2352 x 1568 pixels:
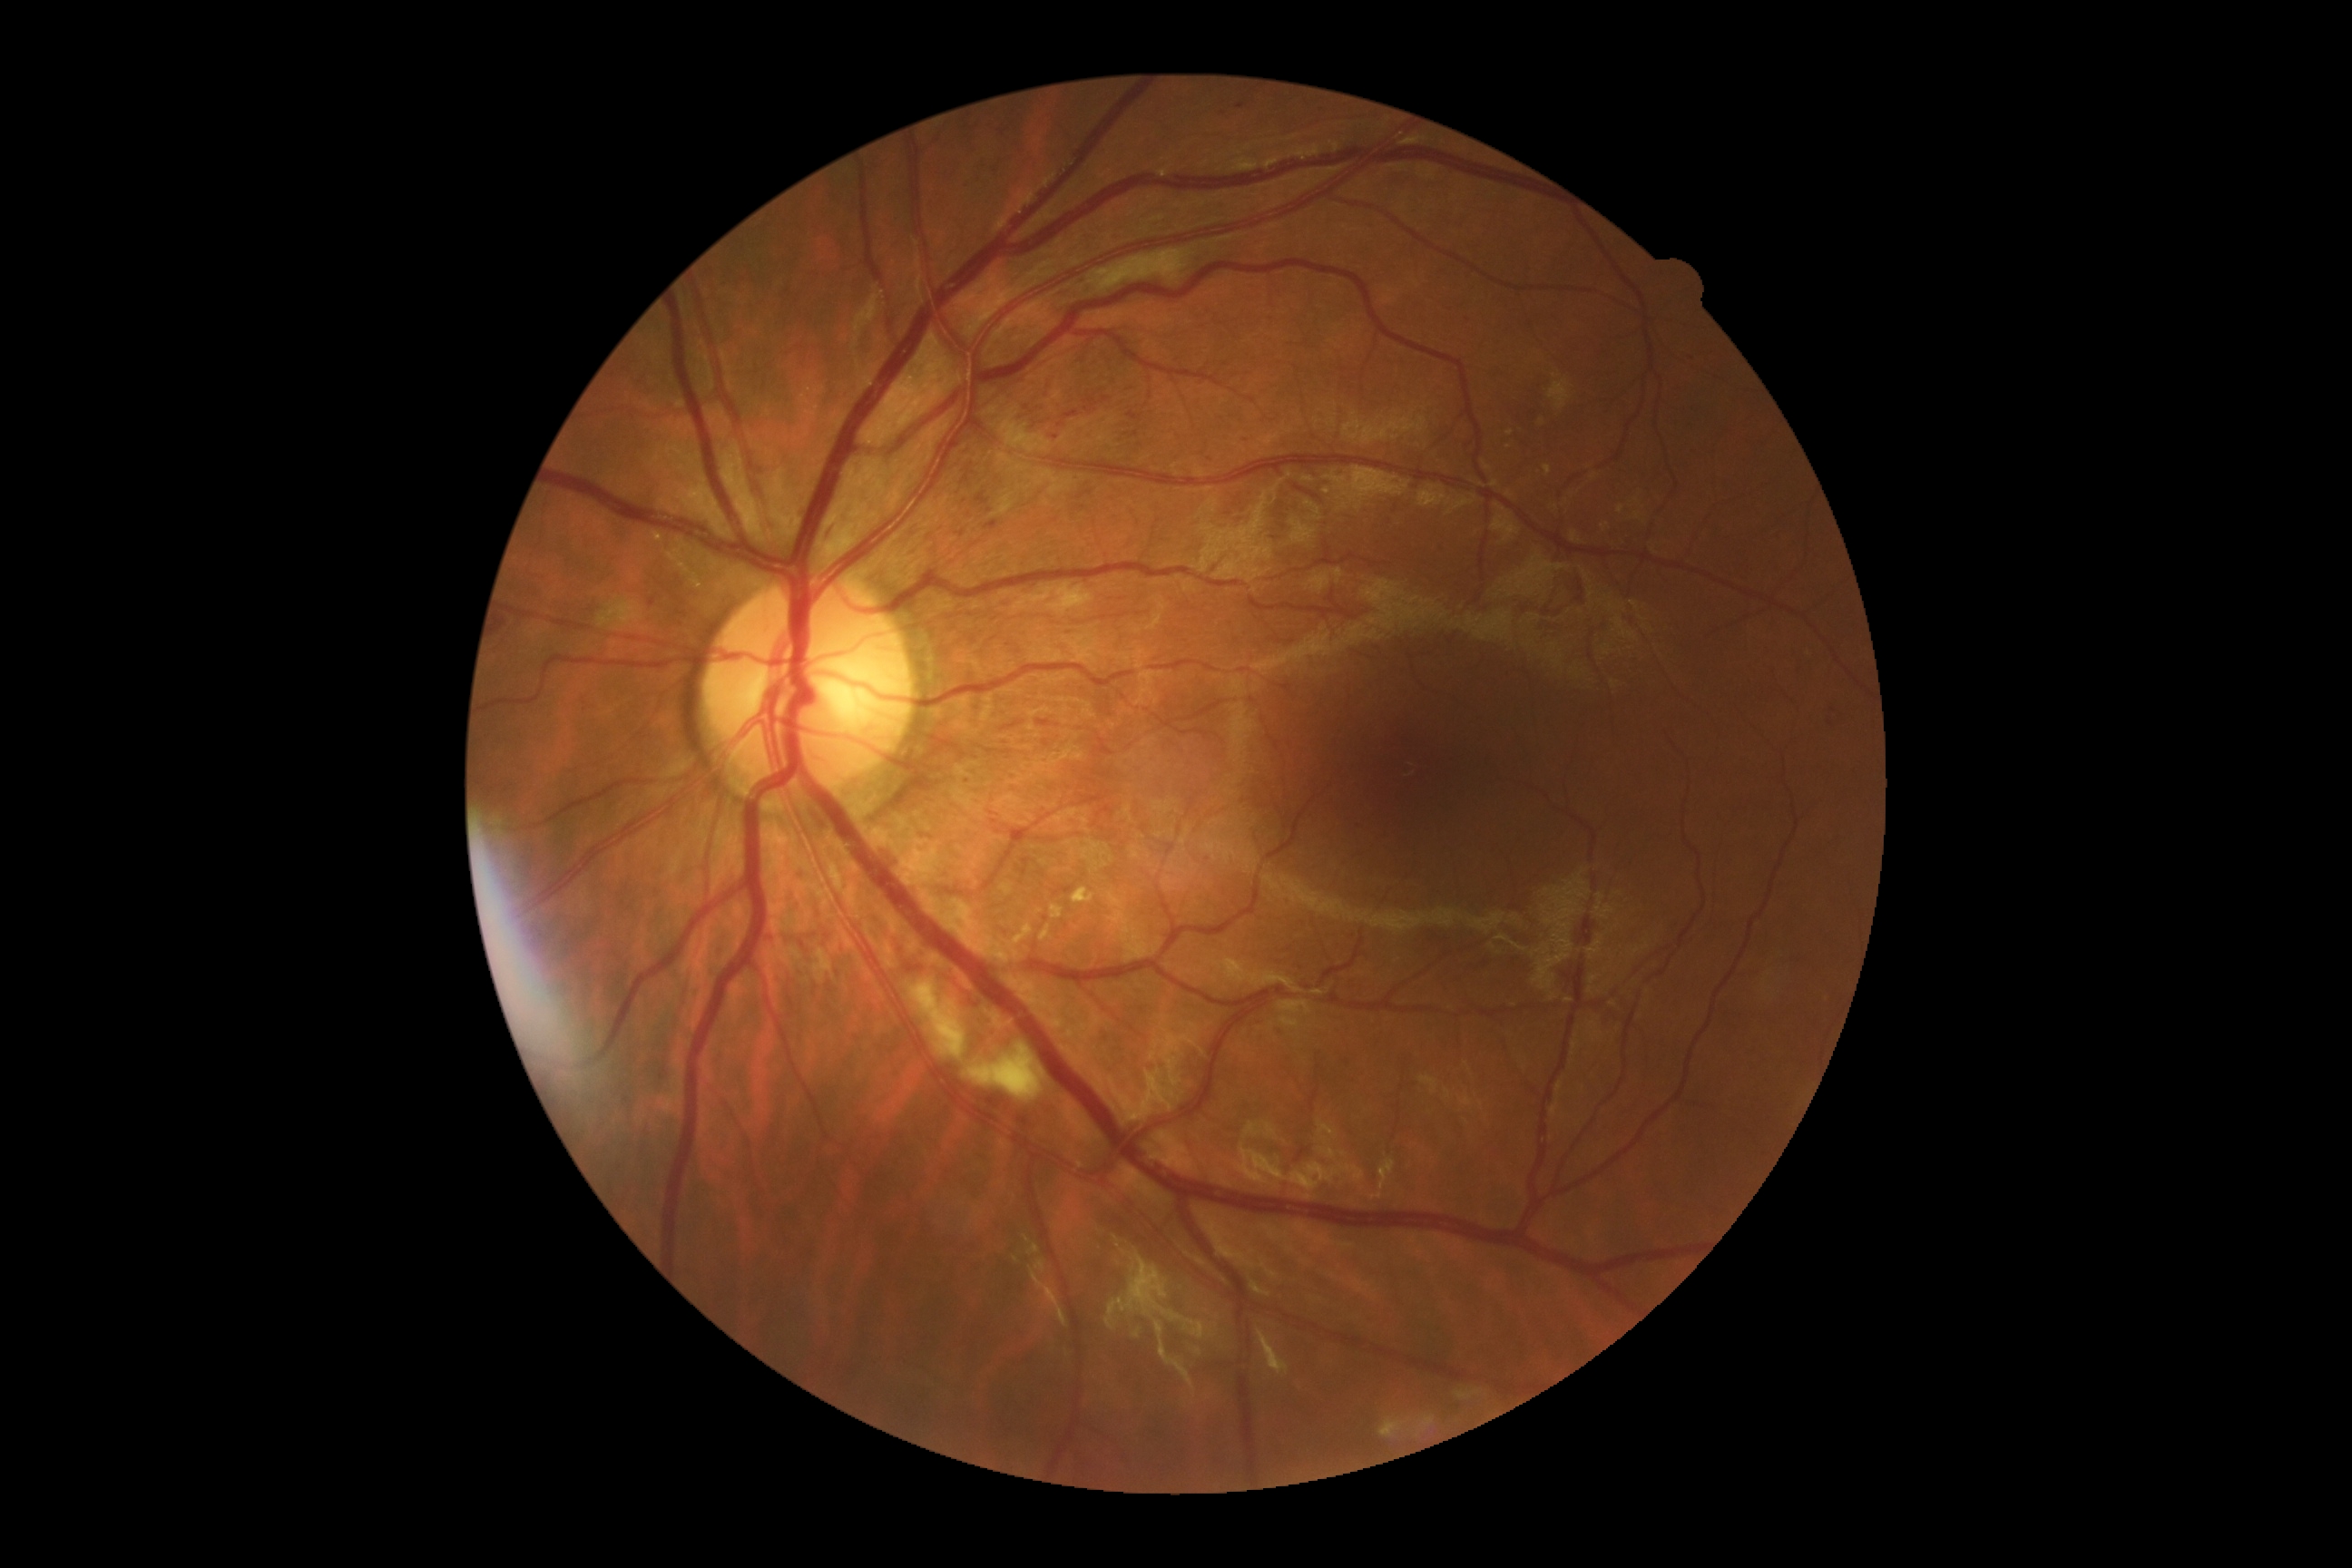

Diabetic retinopathy severity is grade 2.